Acquired with a NIDEK AFC-230 — 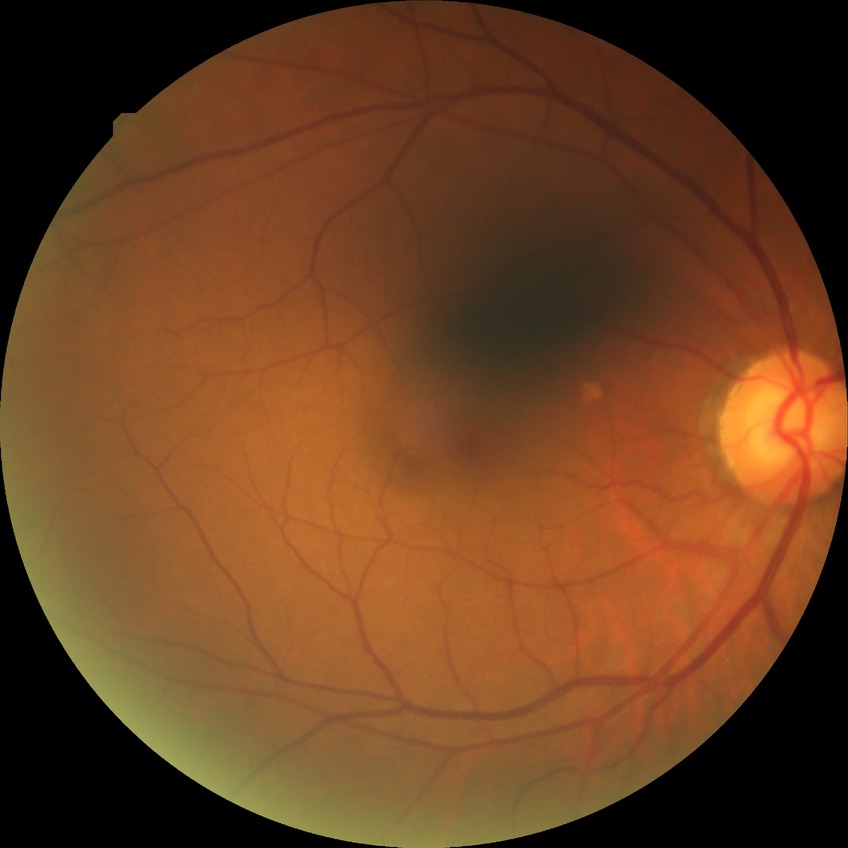
Modified Davis classification: no diabetic retinopathy.